2352 by 1568 pixels.
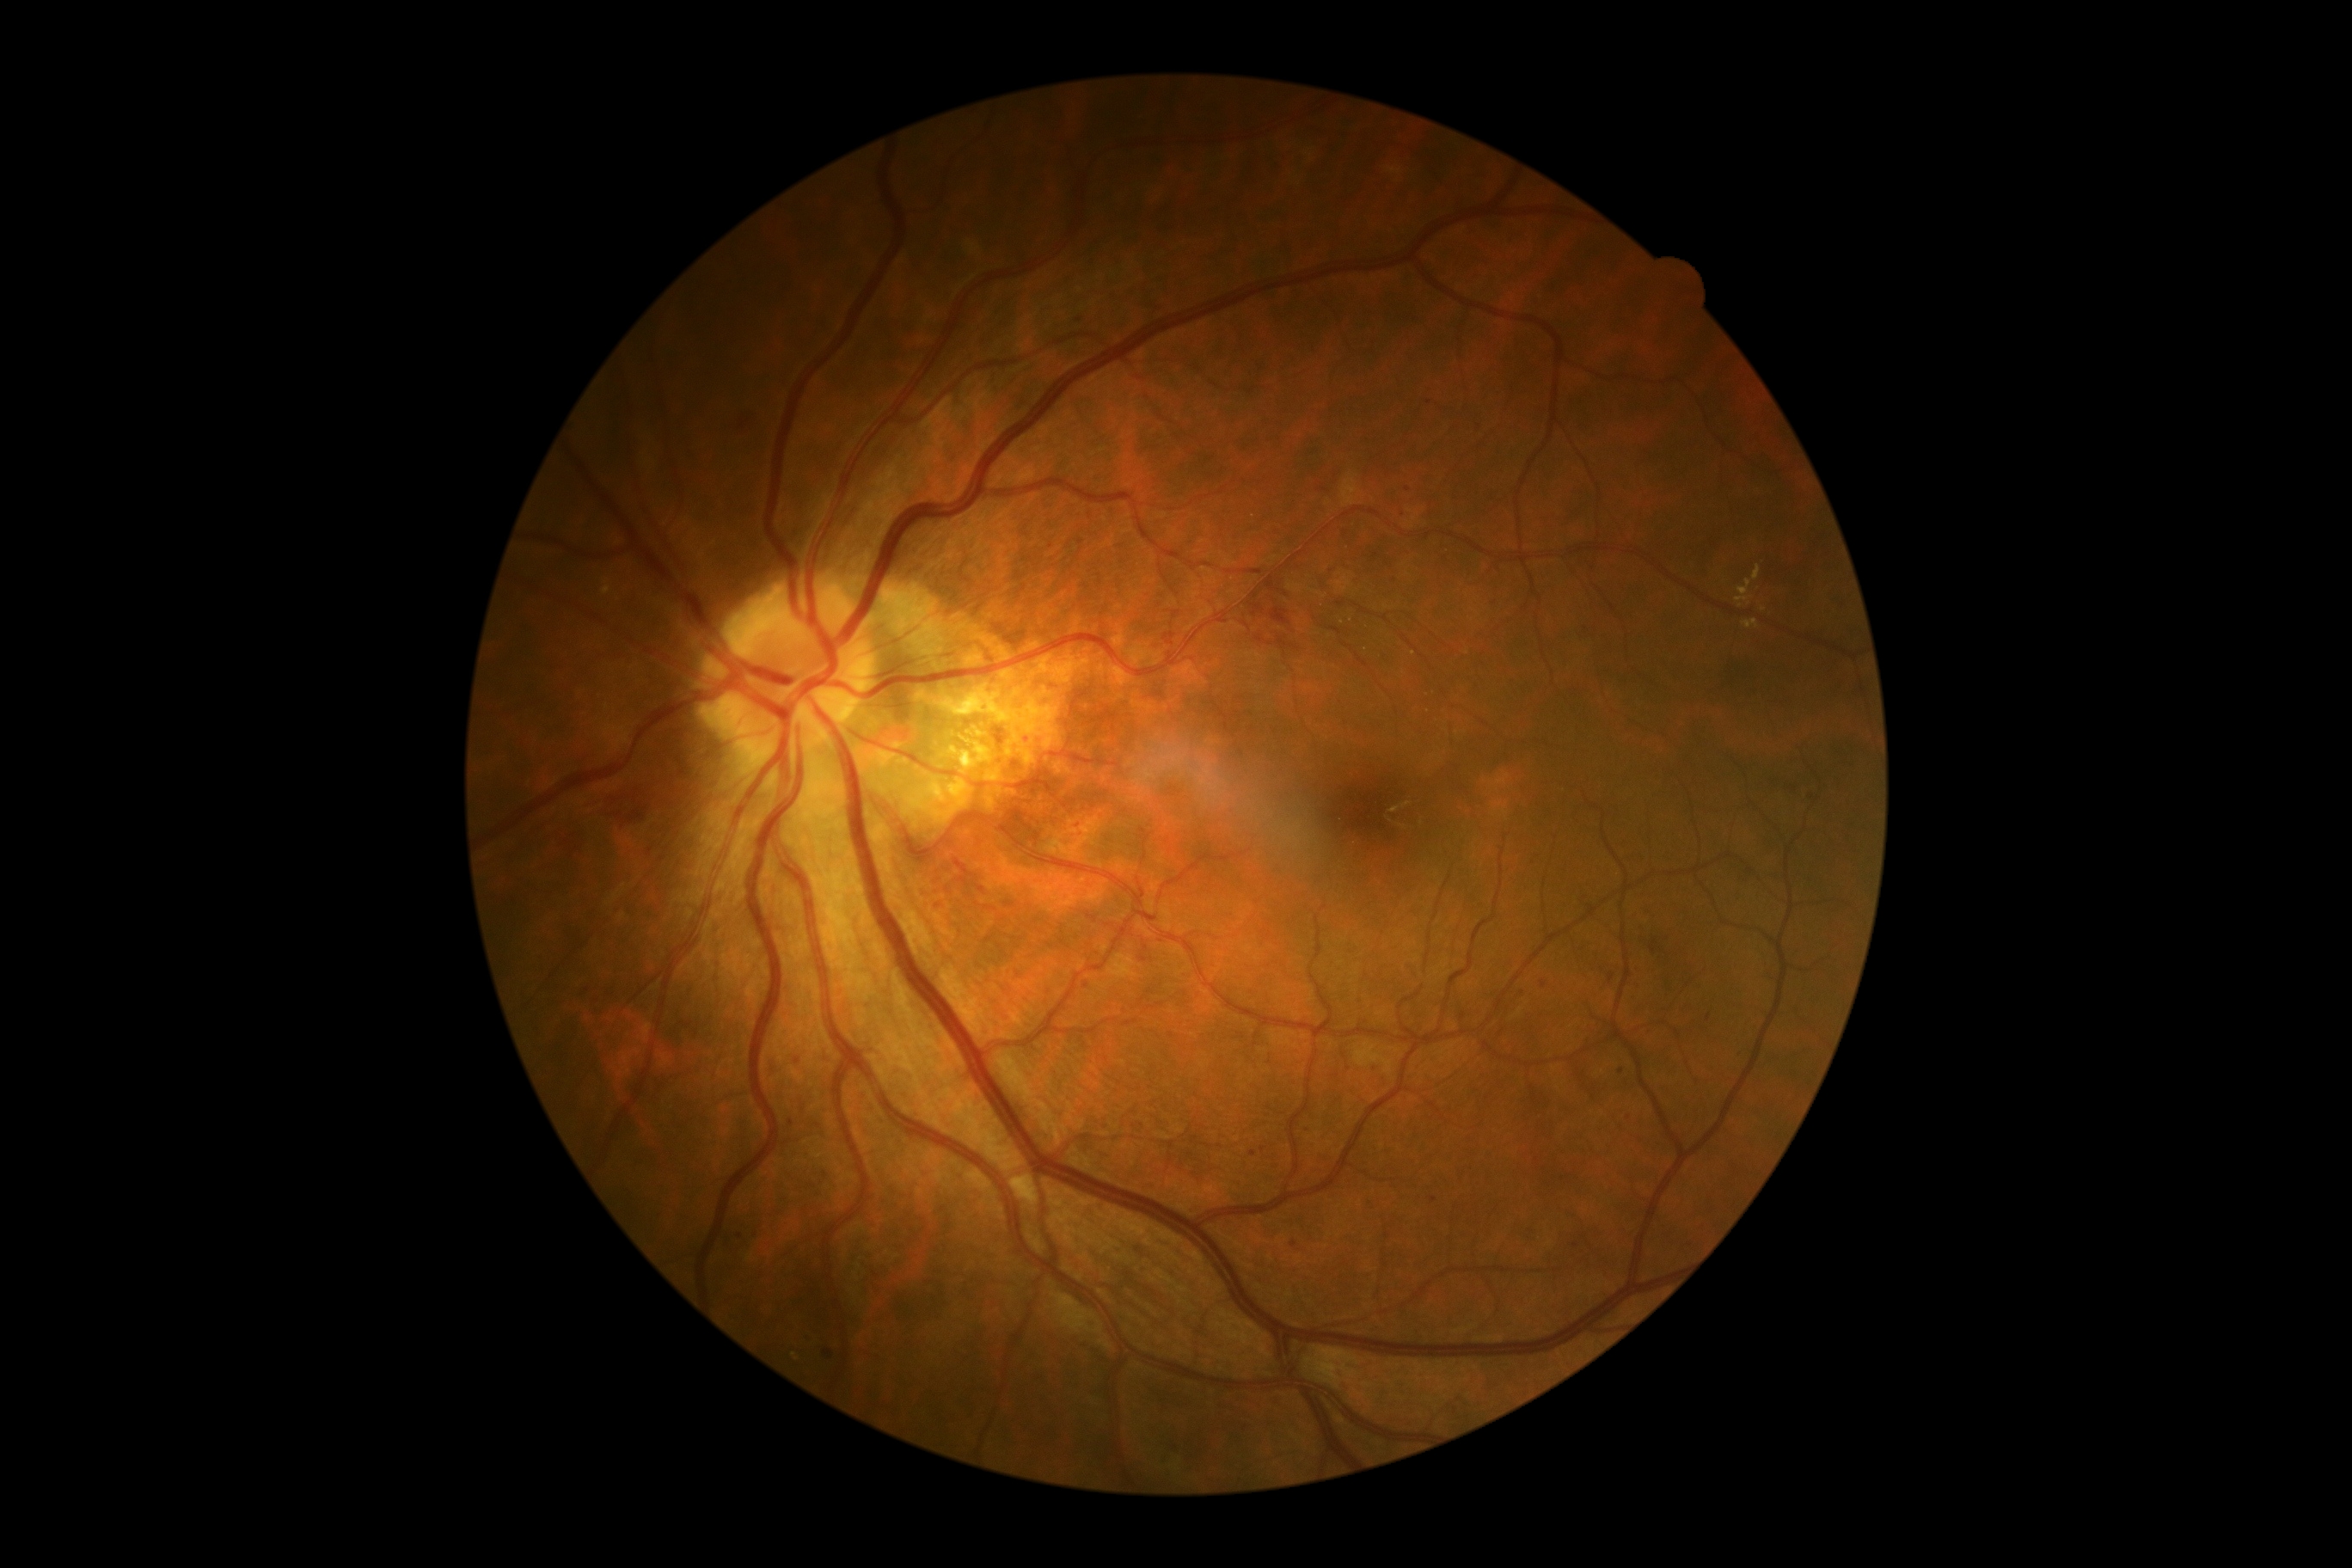

Diabetic retinopathy (DR): 2 — more than just microaneurysms but less than severe NPDR.